Non-mydriatic acquisition.
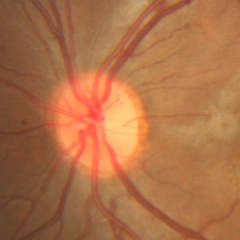 Glaucoma stage = no evidence of glaucoma.